Color fundus photograph. 2352x1568.
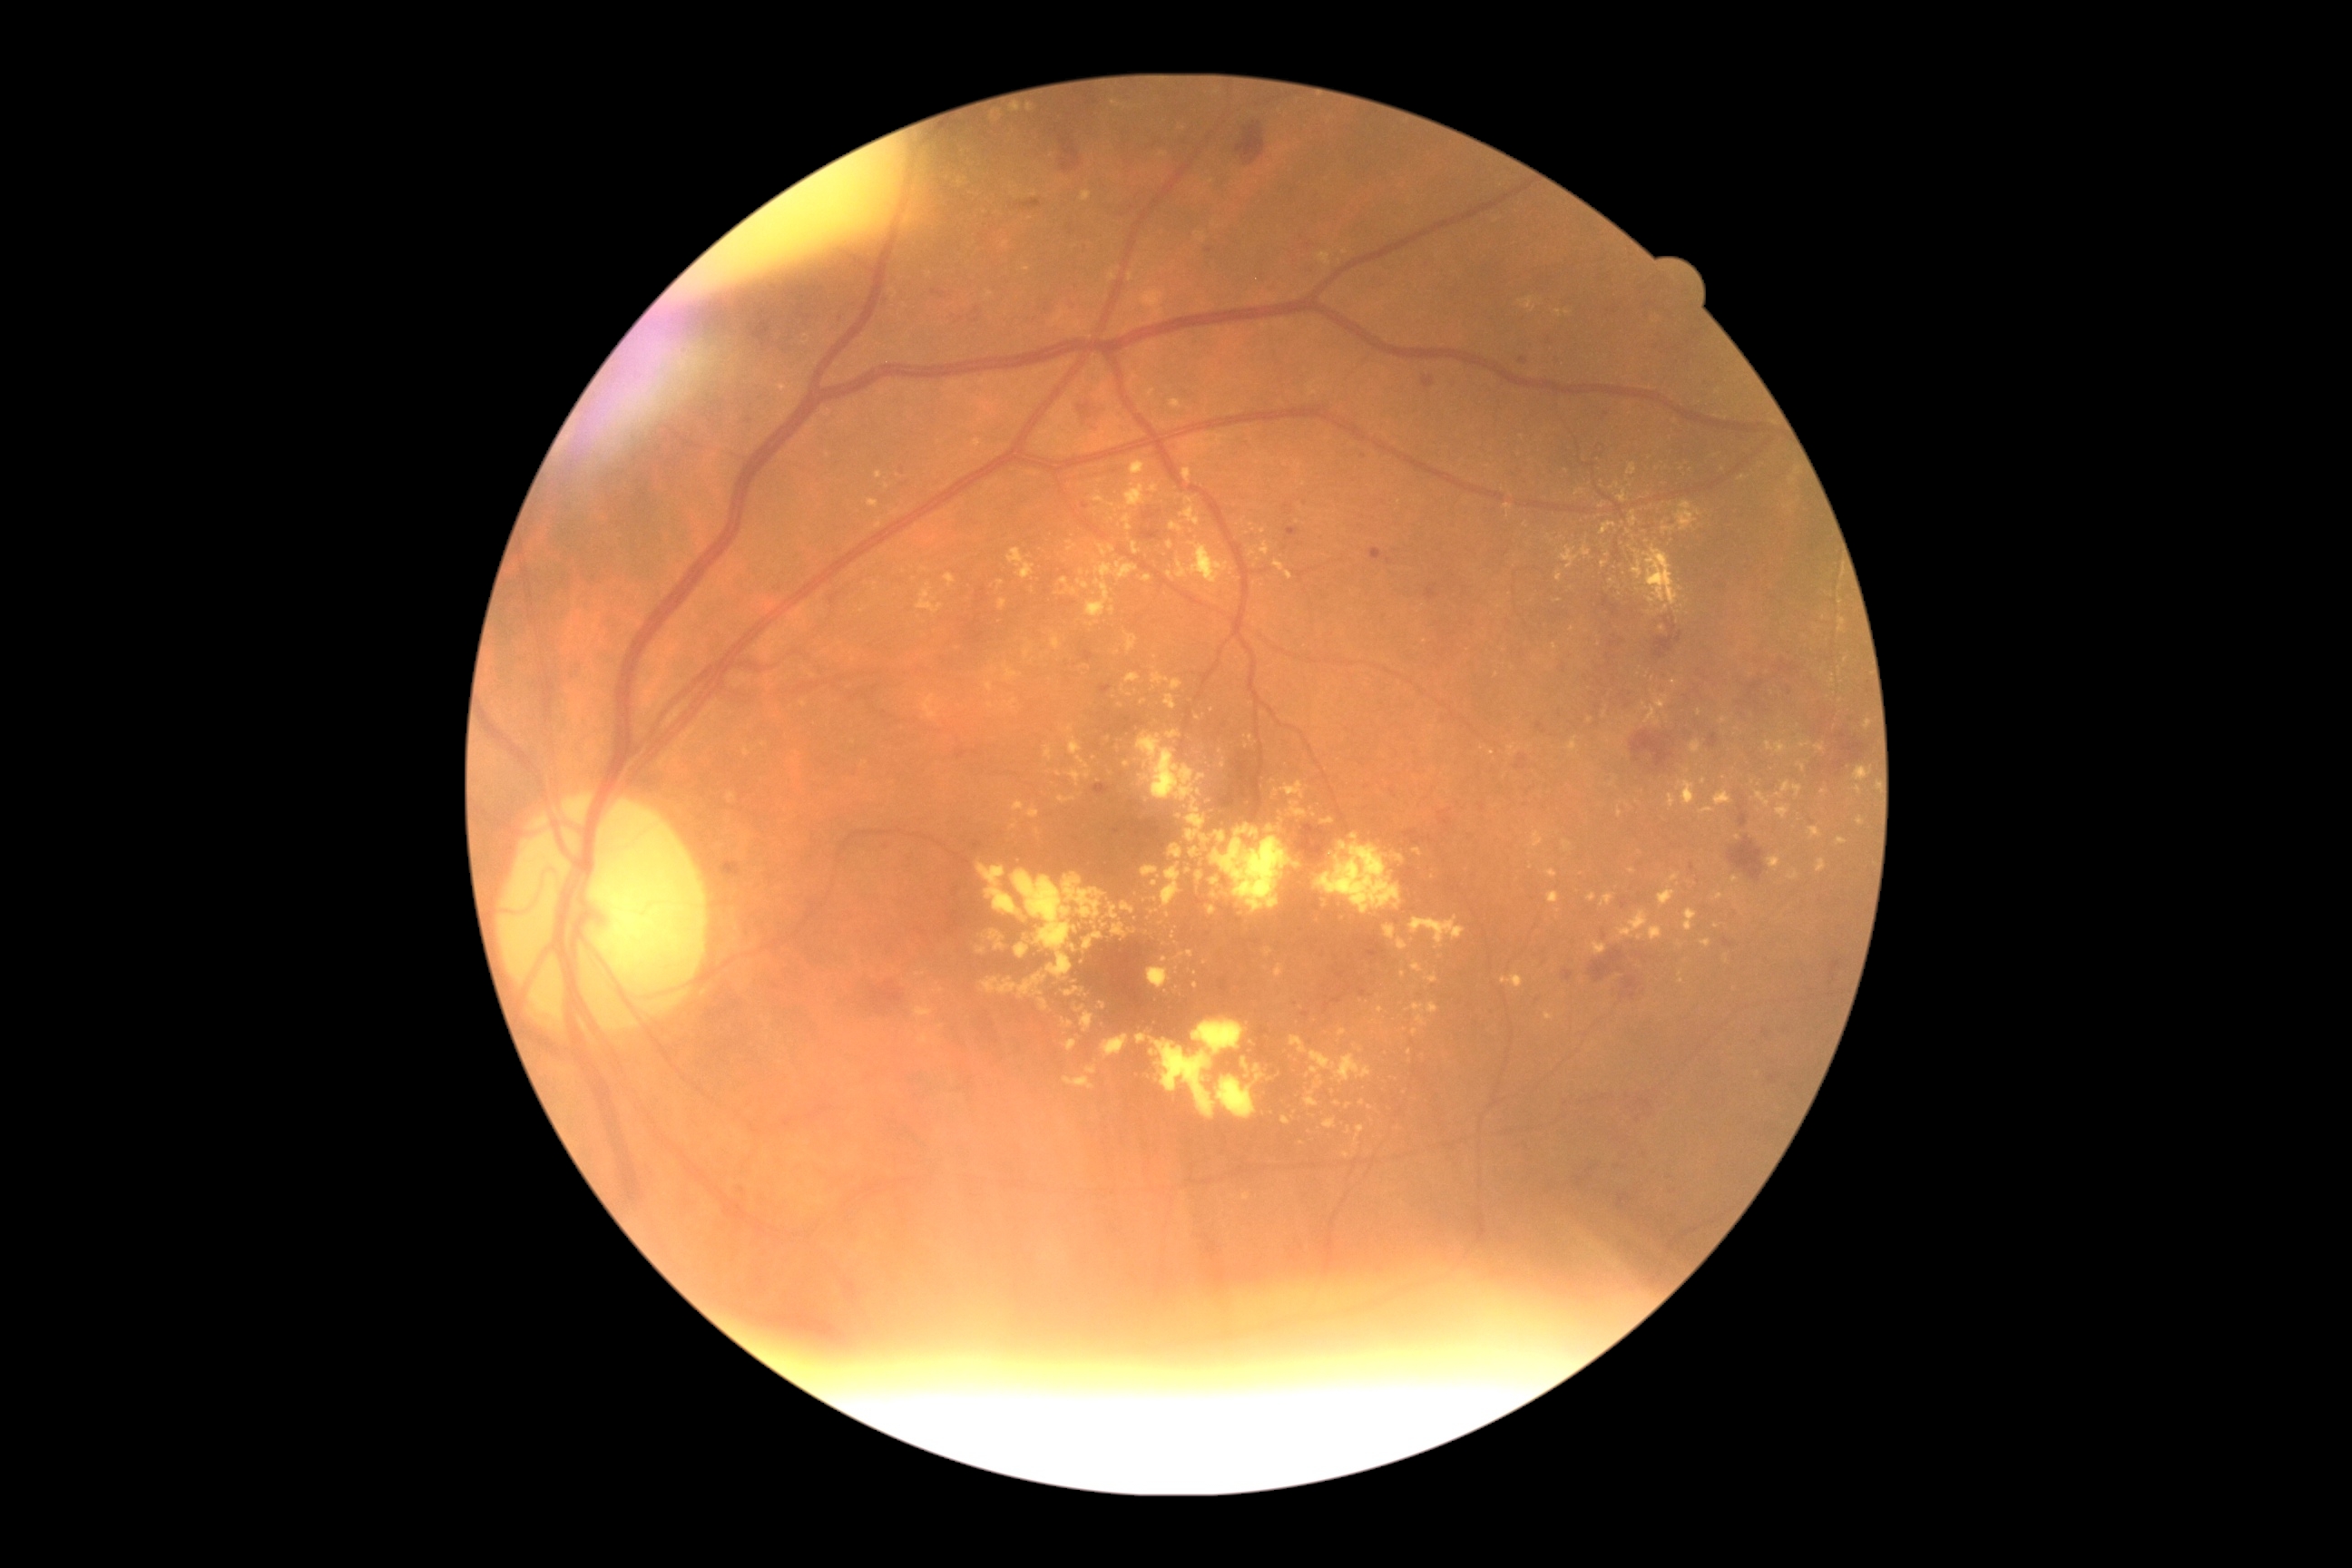 DR stage: grade 2.
EXs include those at <box>1081,1012,1095,1034</box>; <box>1560,547,1591,569</box>; <box>1028,807,1041,819</box>; <box>1832,674,1836,683</box>; <box>1211,877,1230,890</box>; <box>1320,819,1335,825</box>; <box>968,190,977,199</box>; <box>999,600,1008,611</box>; <box>945,574,956,587</box>; <box>1304,1052,1373,1106</box>; <box>1275,965,1284,979</box>; <box>1563,841,1571,850</box>.
Additional small EXs near [1206, 963]; [1410, 1052]; [1133, 932]; [1801, 766]; [1433, 877]; [1112, 276]; [934, 600].